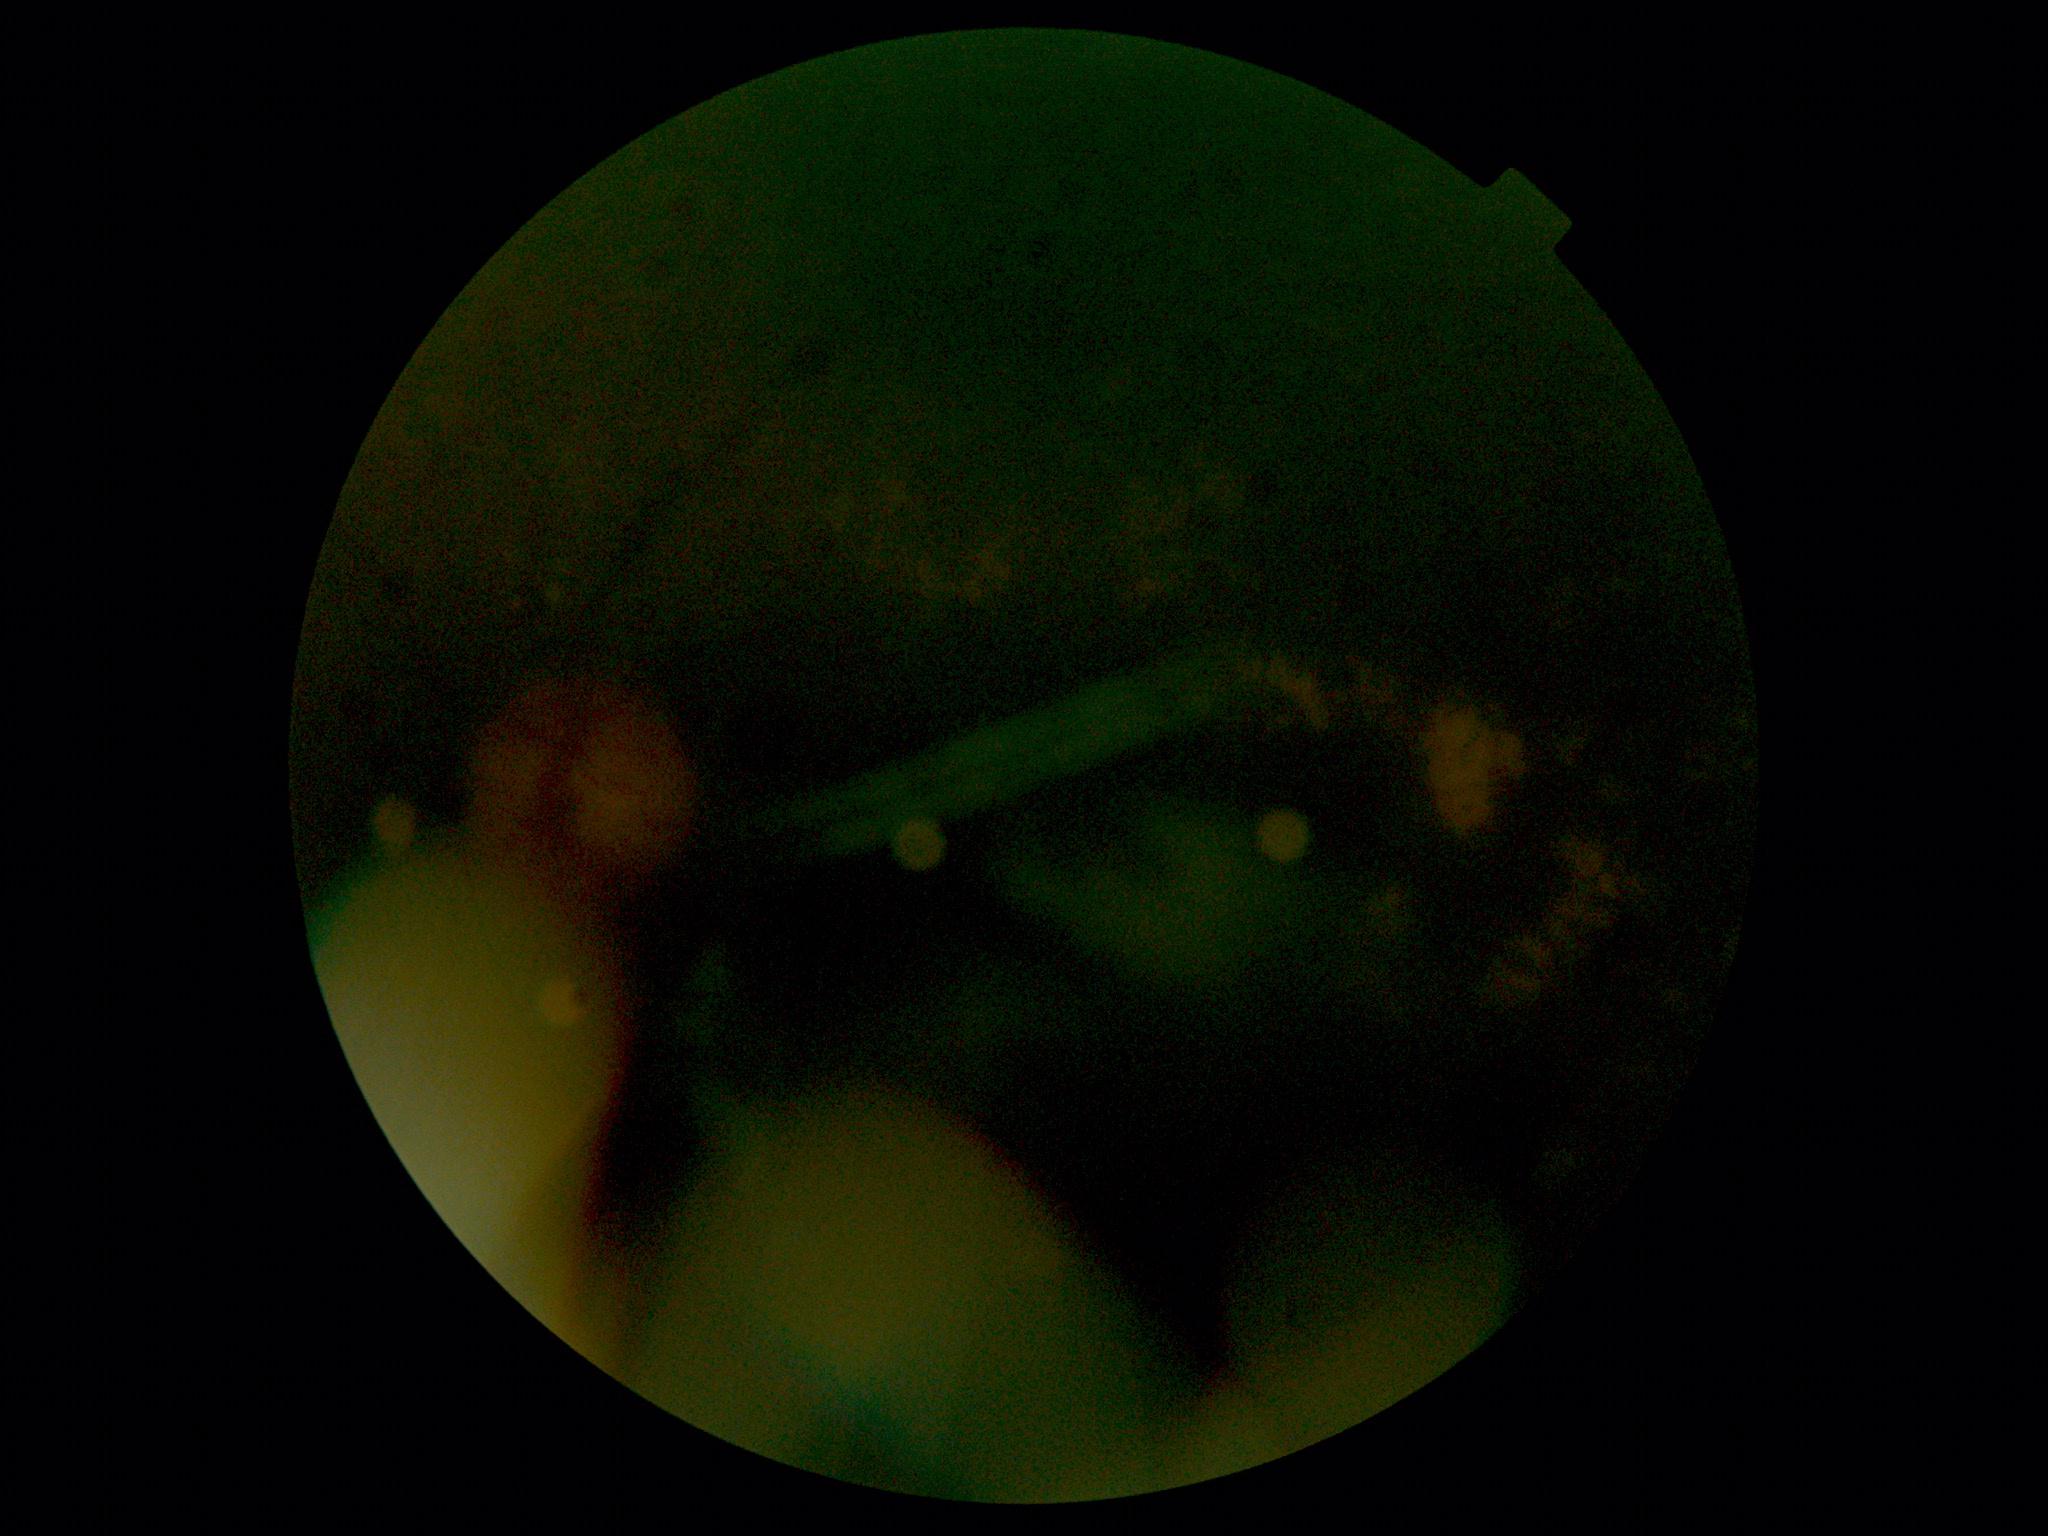 – DR grade: 2 (moderate NPDR) — more than just microaneurysms but less than severe NPDR
– DR class: non-proliferative diabetic retinopathy